2212 by 1659 pixels.
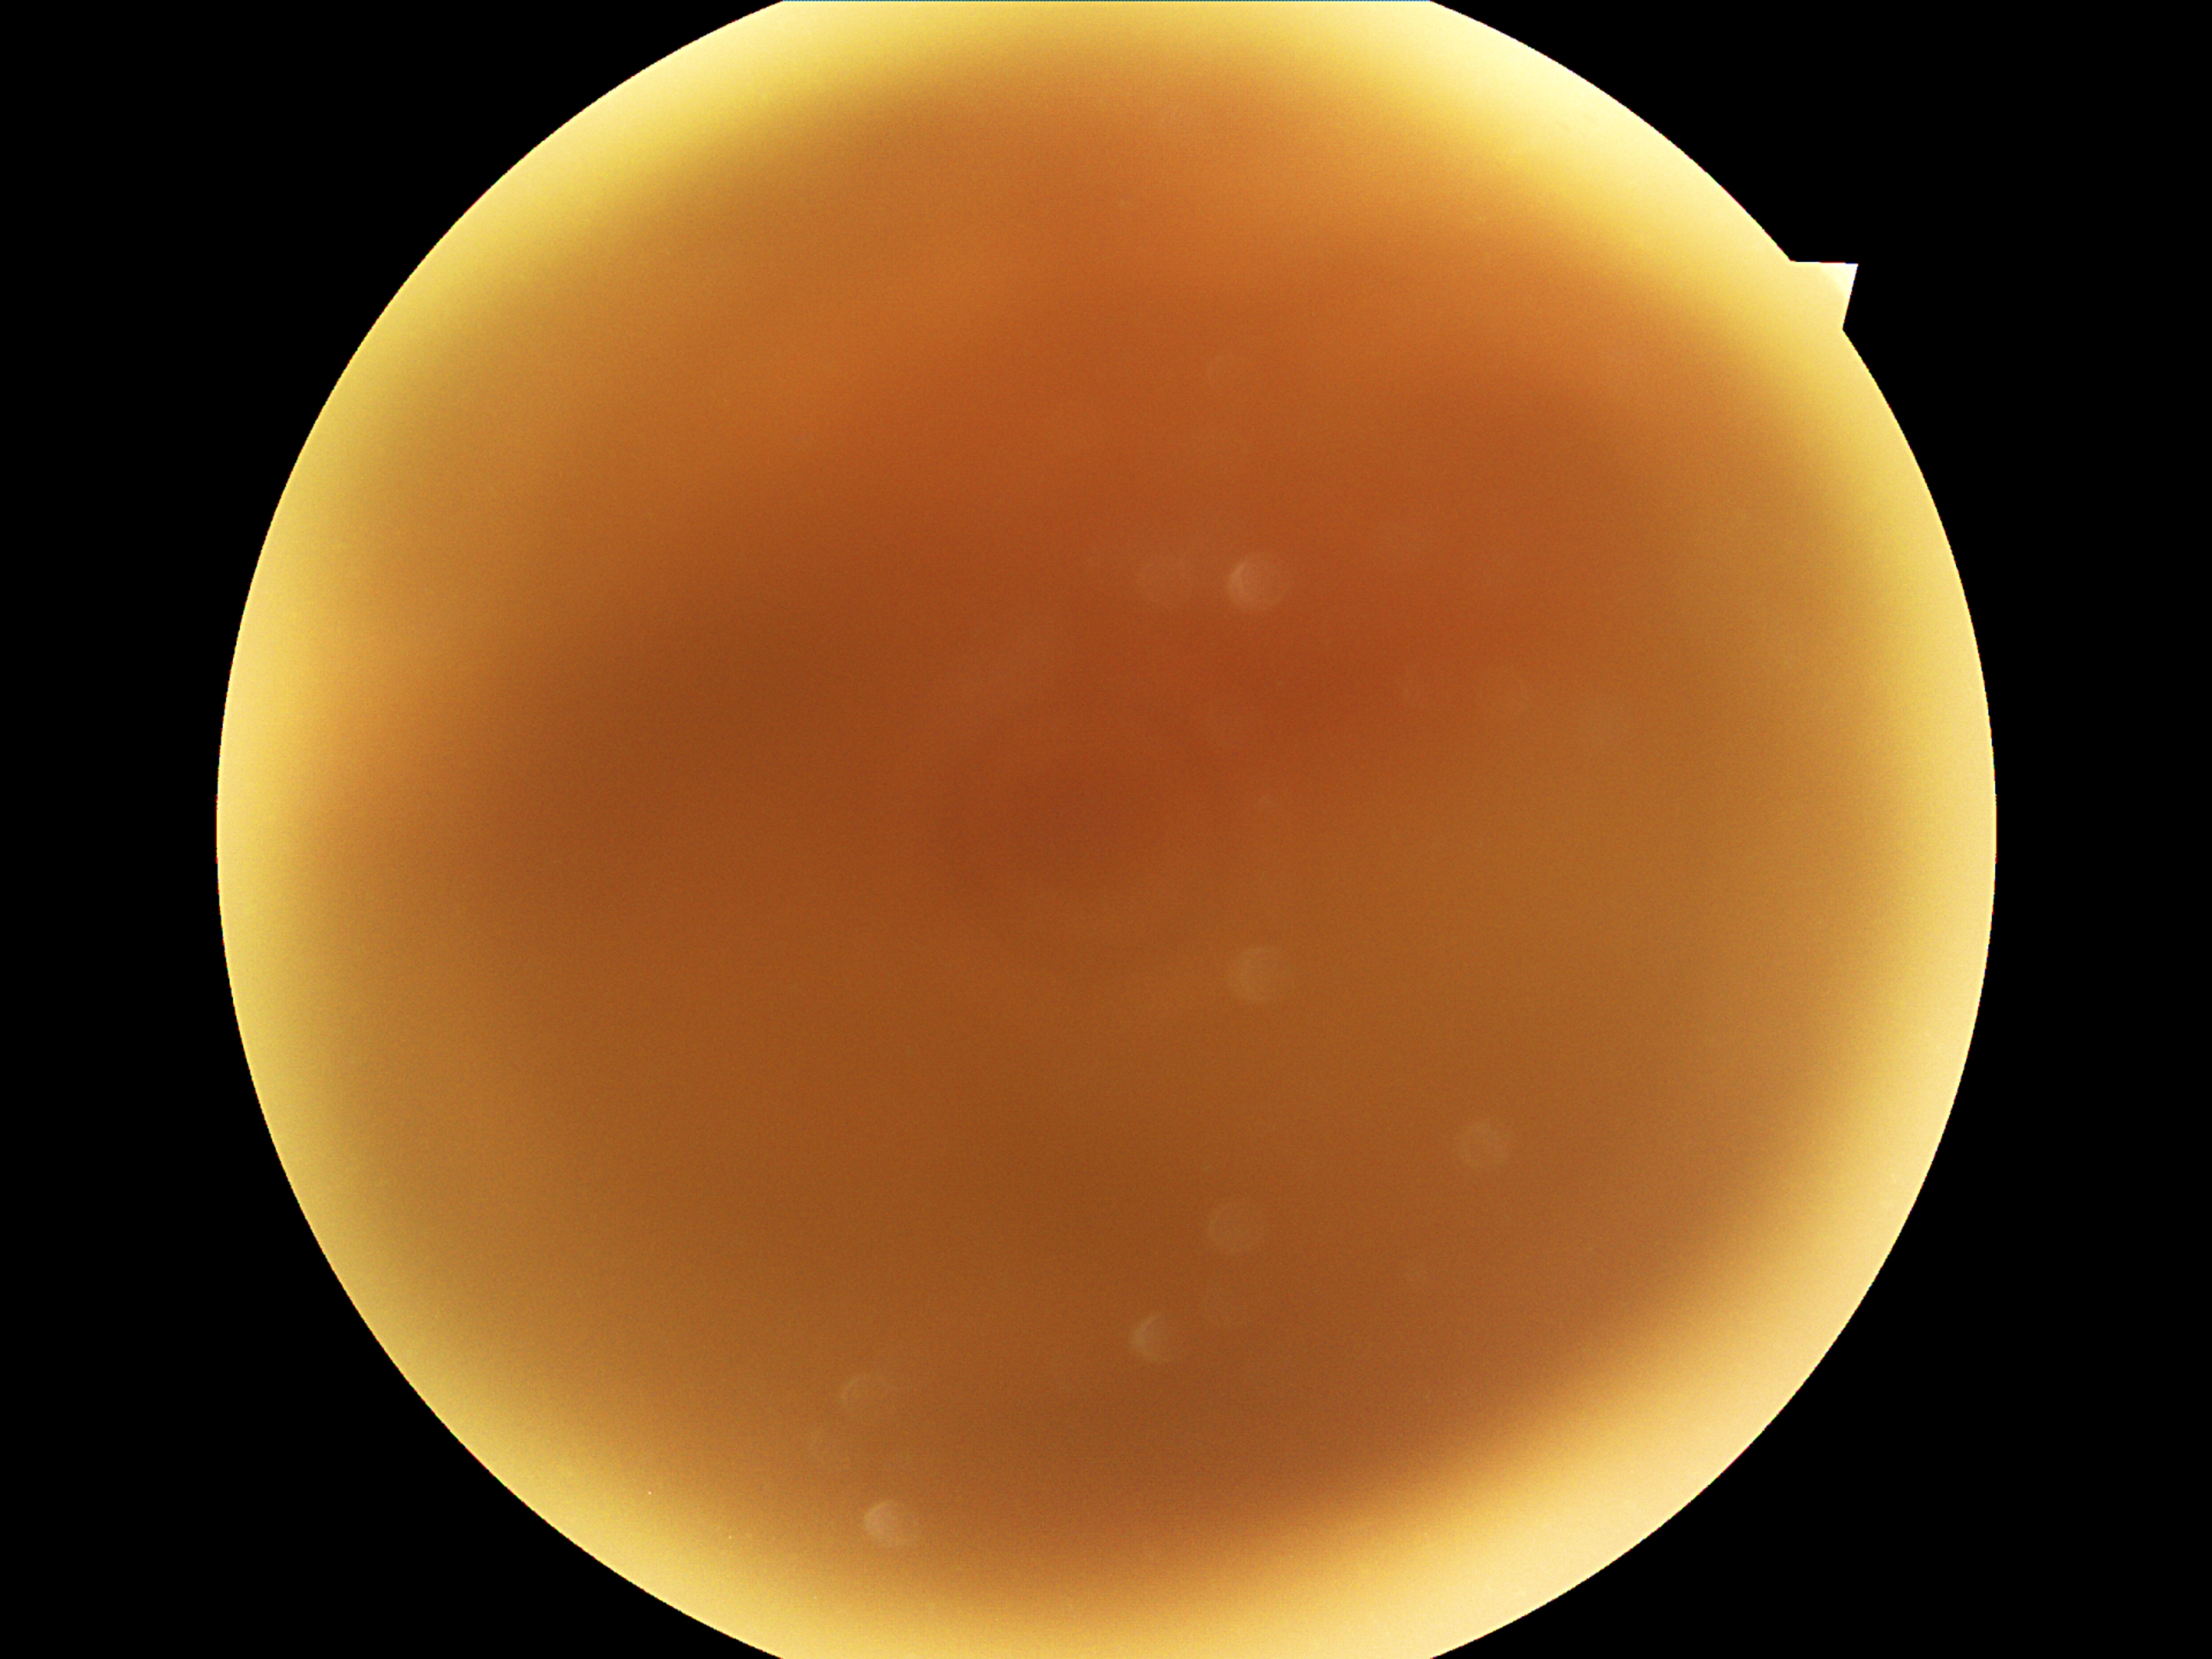

DR severity: ungradable.